Retinal fundus photograph; 2352 x 1568 pixels
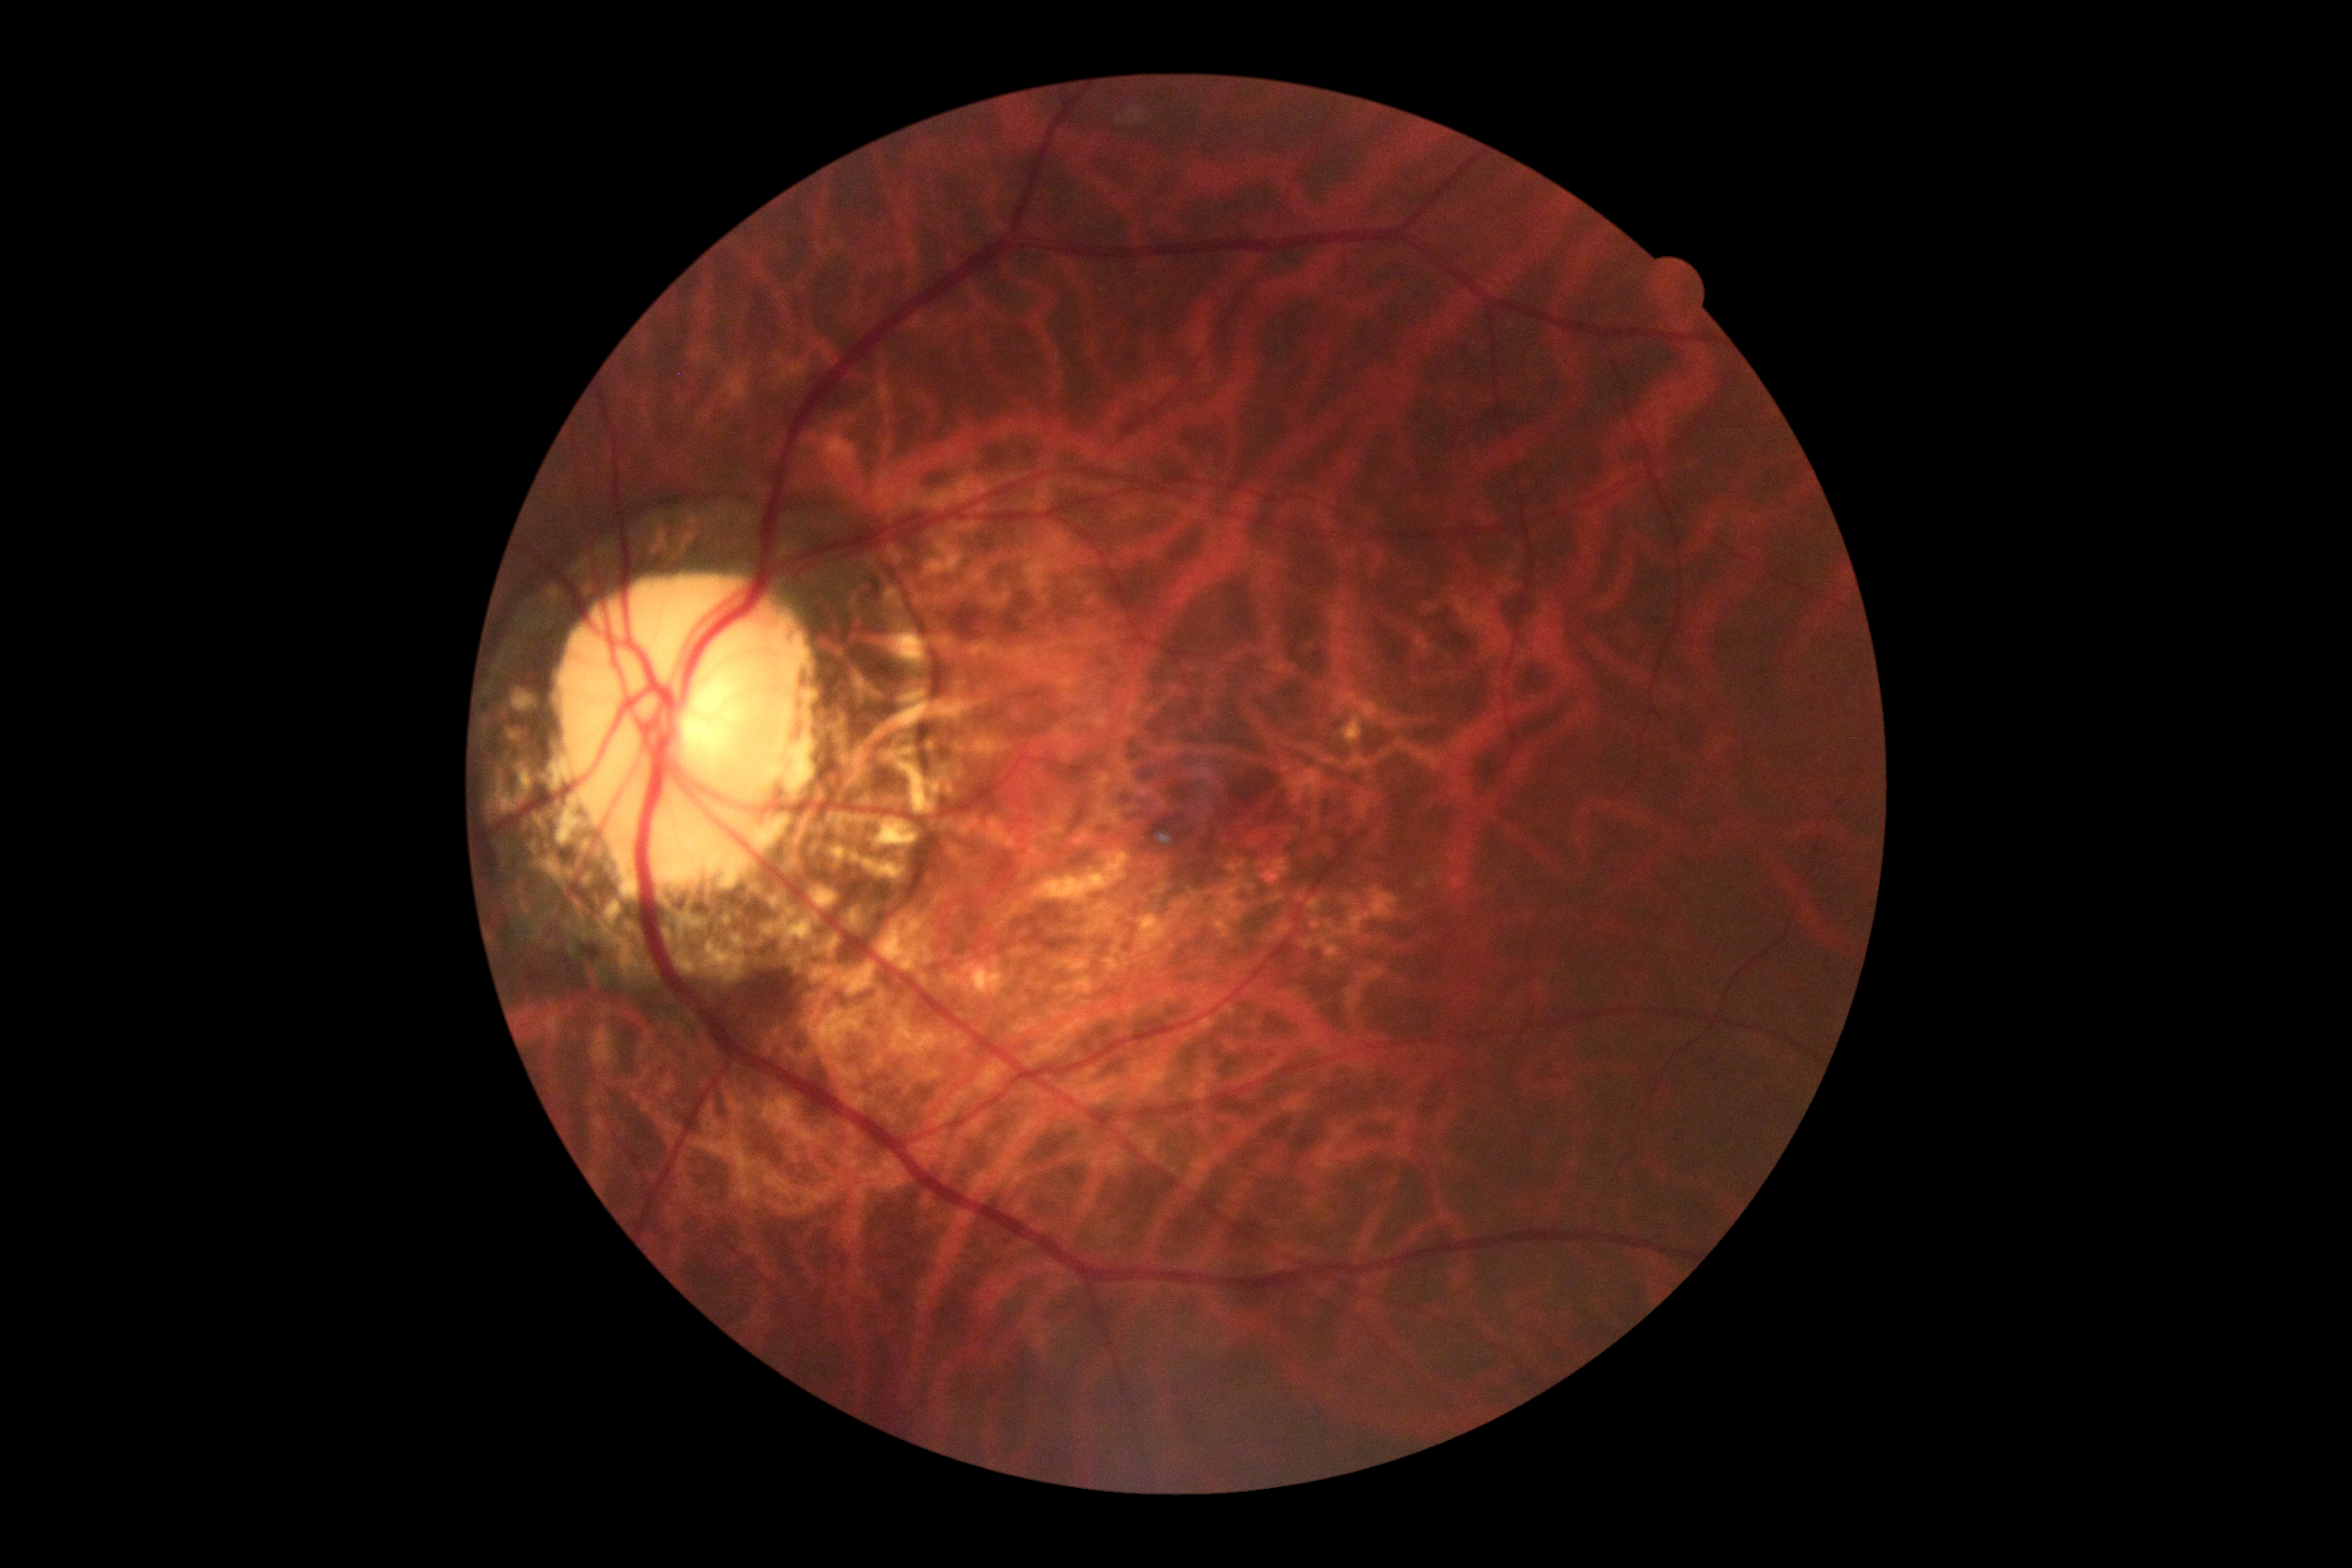 DR impression: no signs of DR
retinopathy: no apparent diabetic retinopathy (grade 0)